Davis DR grading — 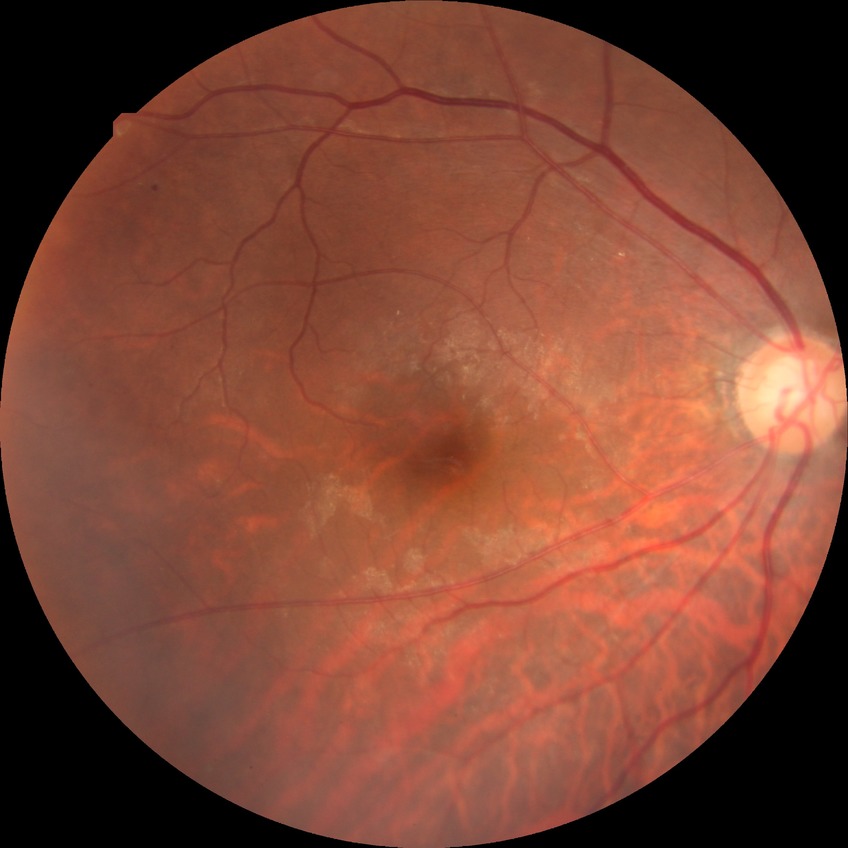
diabetic retinopathy (DR)=simple diabetic retinopathy (SDR).